45° FOV · no pharmacologic dilation
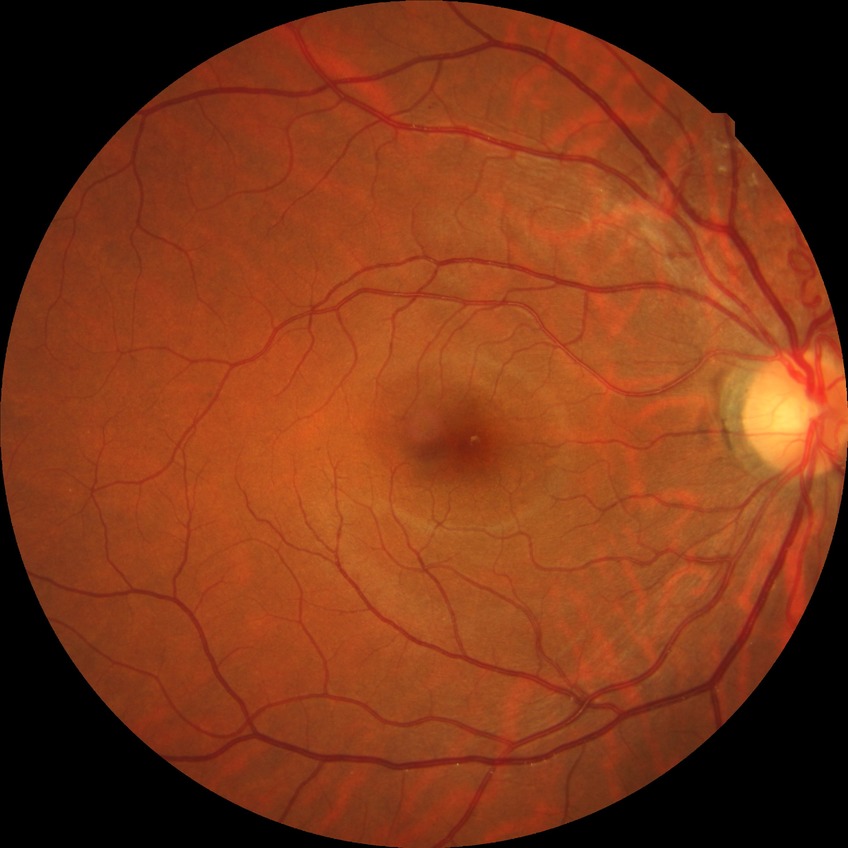

Diabetic retinopathy (DR): no diabetic retinopathy (NDR).